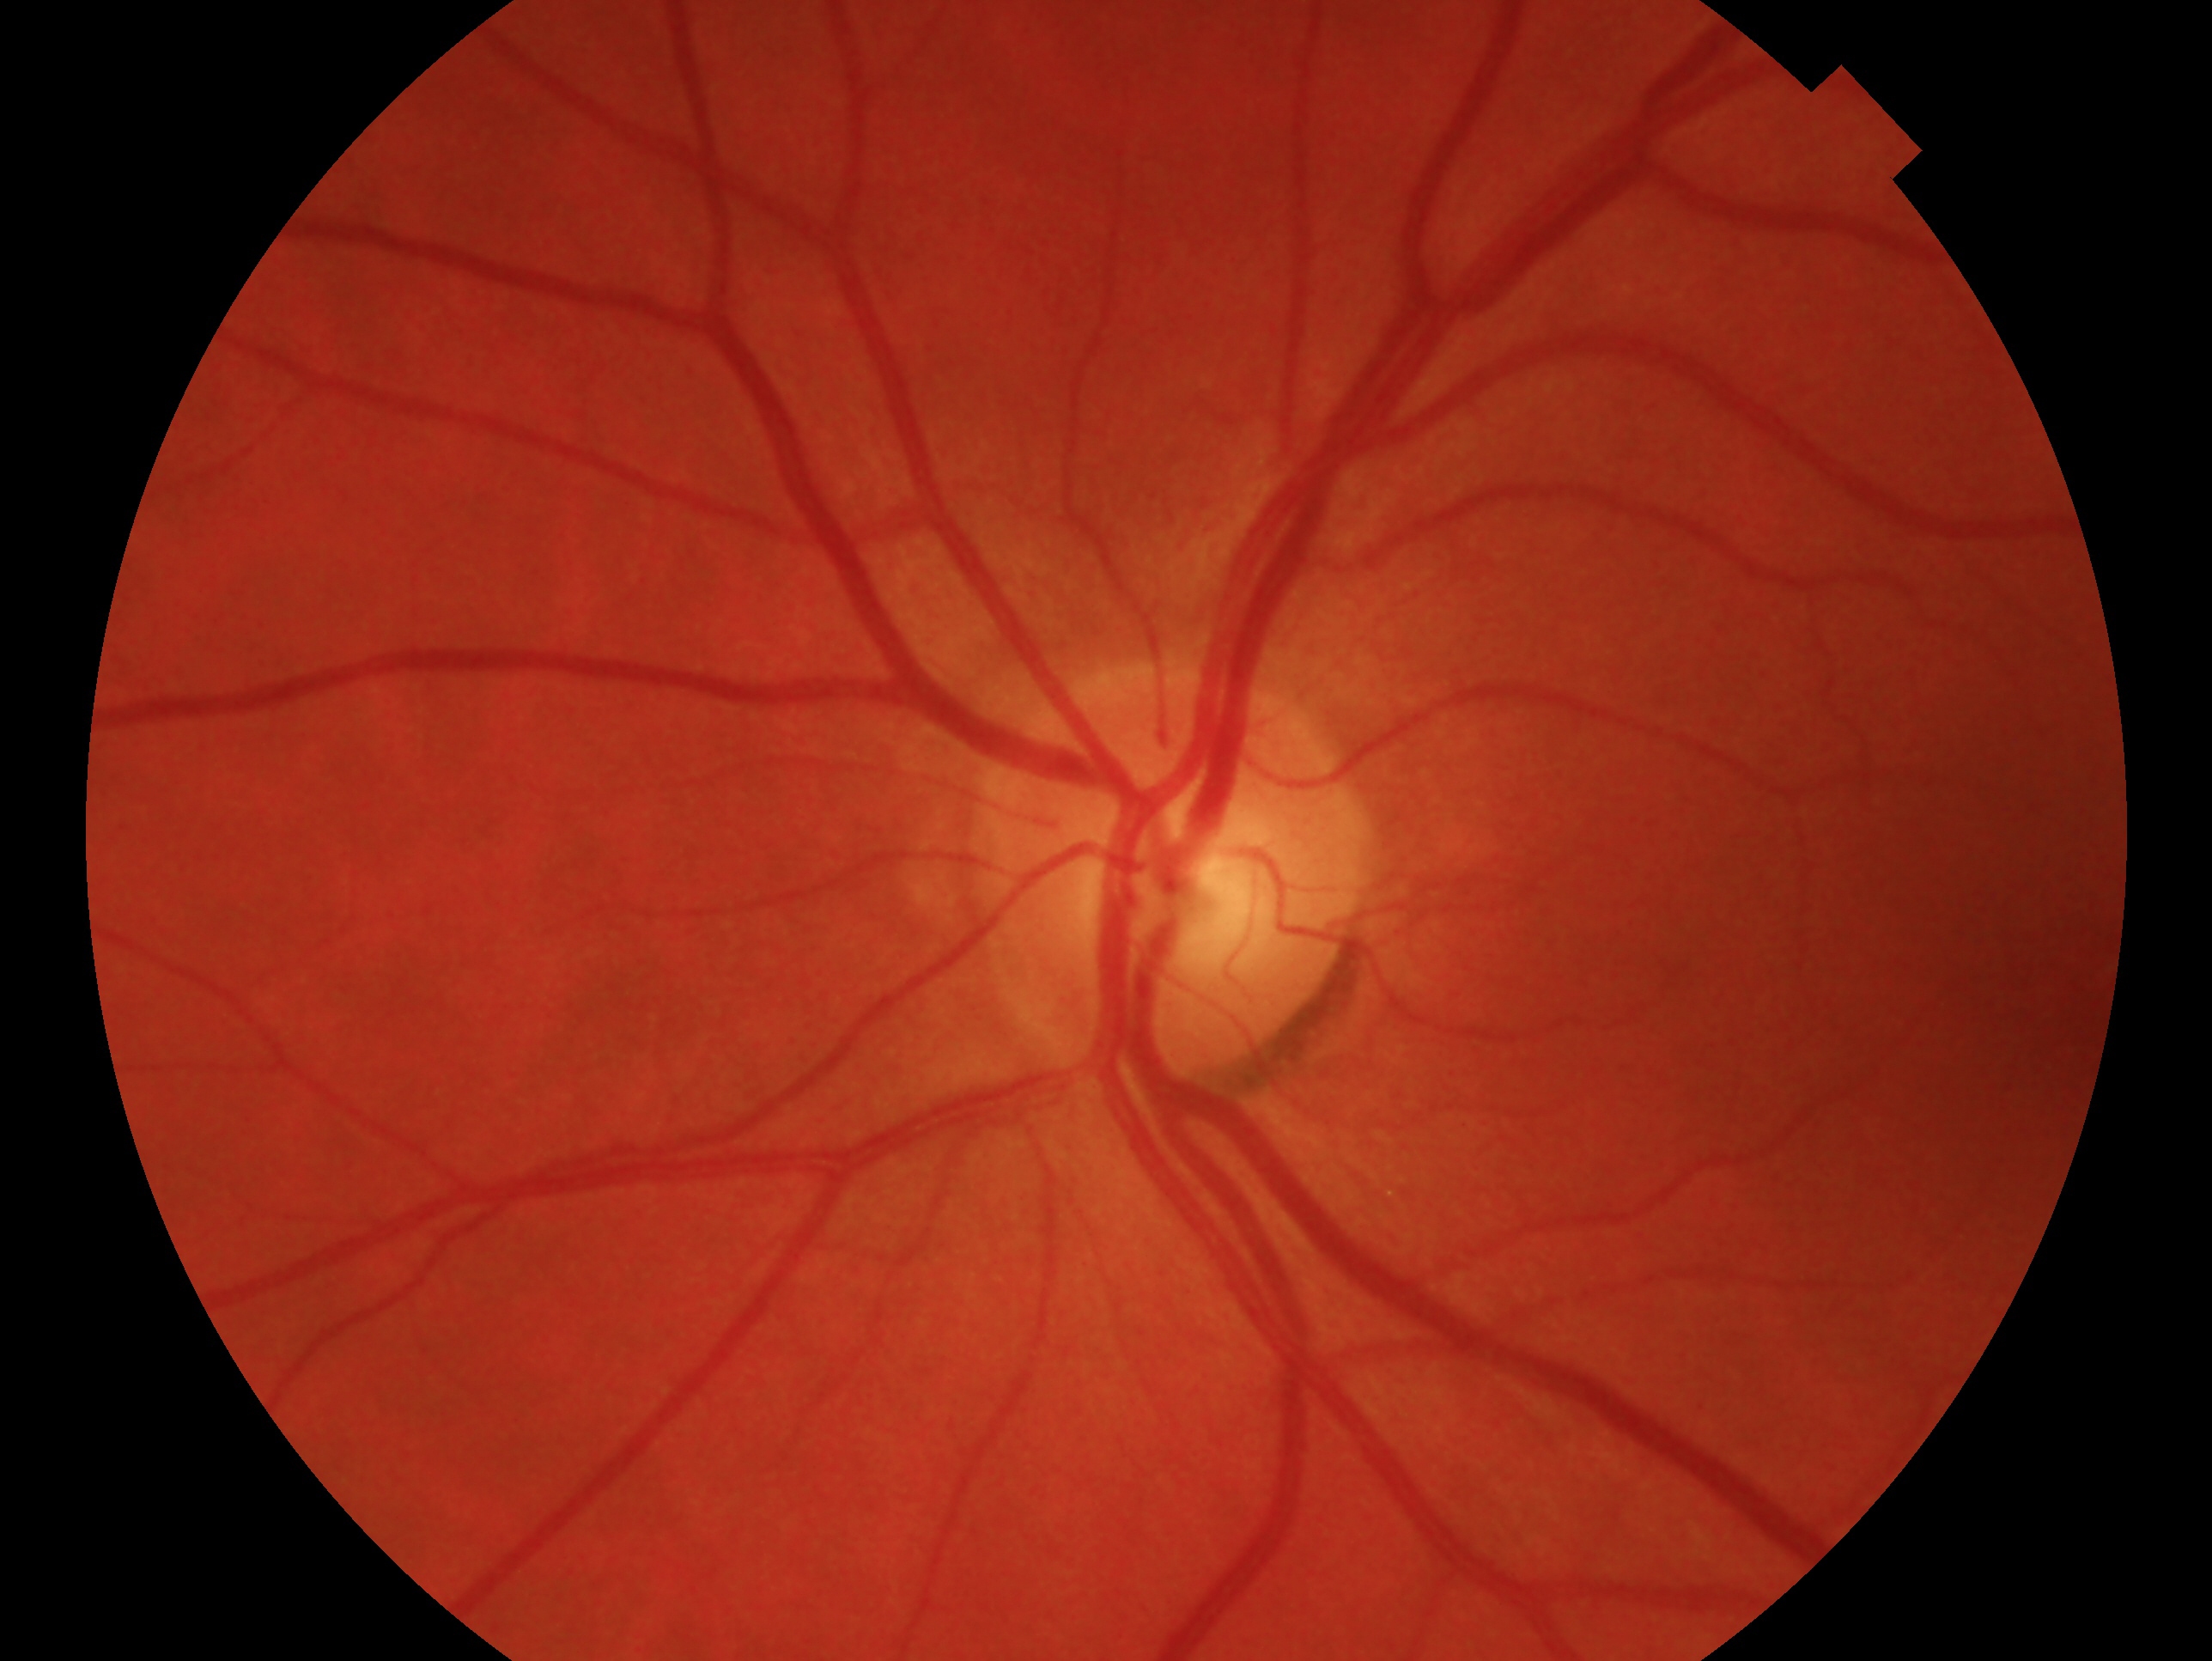
Findings:
– clinical classification — negative for glaucoma
– laterality — left